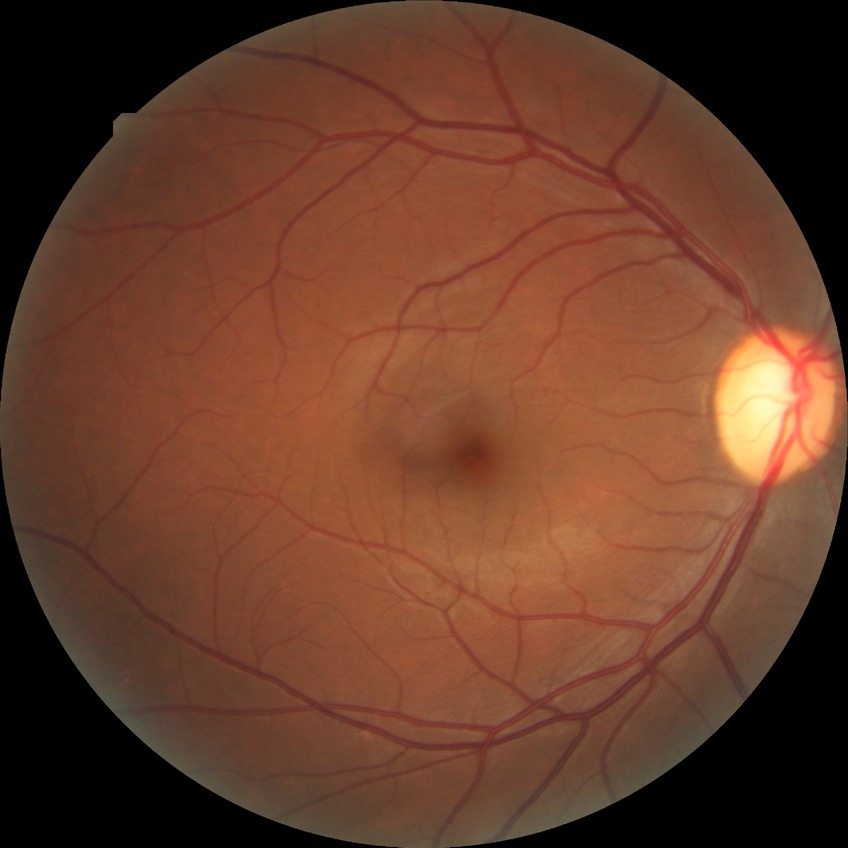 Annotations:
* Davis grading: no diabetic retinopathy